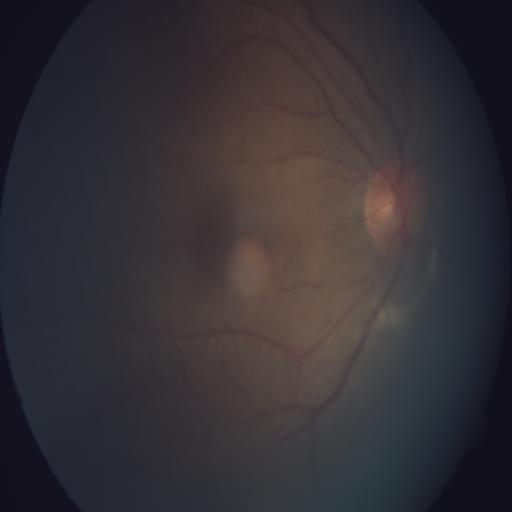
The image shows tilted disc (TD).